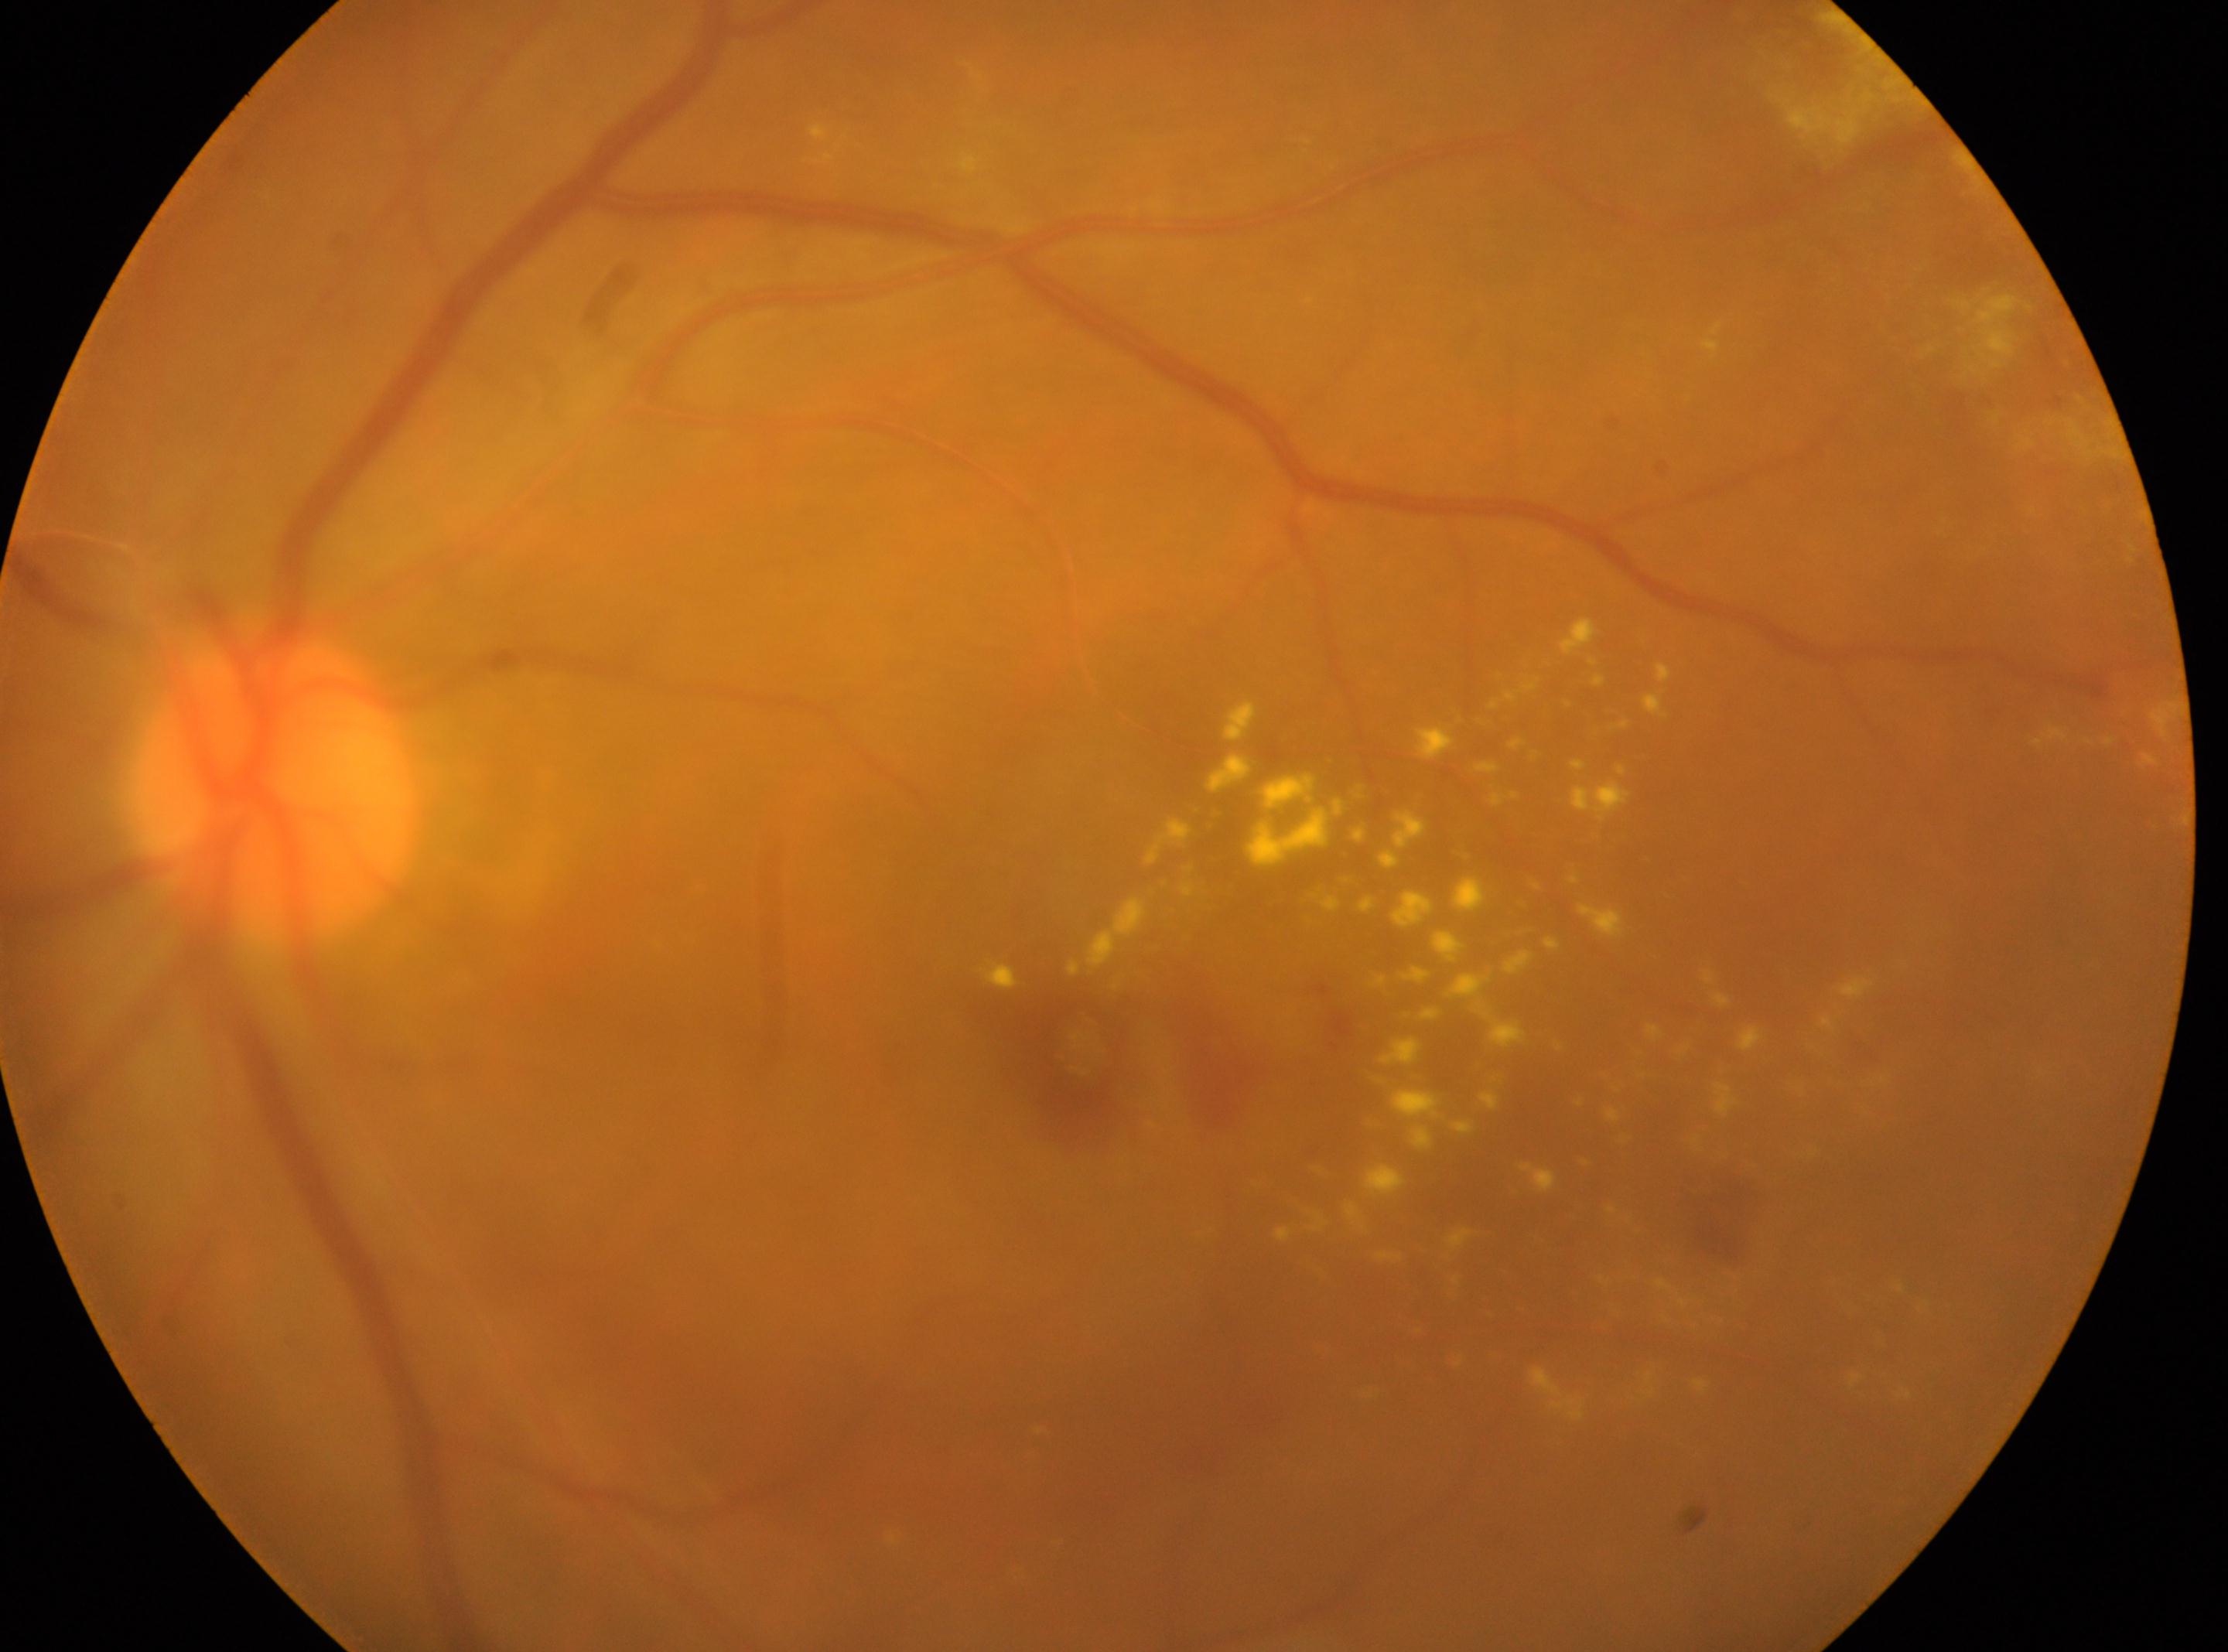 Findings:
- DR class: non-proliferative diabetic retinopathy
- retinopathy: moderate non-proliferative diabetic retinopathy (grade 2)
- eye: OS
- optic disc: 272px, 790px
- fovea: 1071px, 1052px